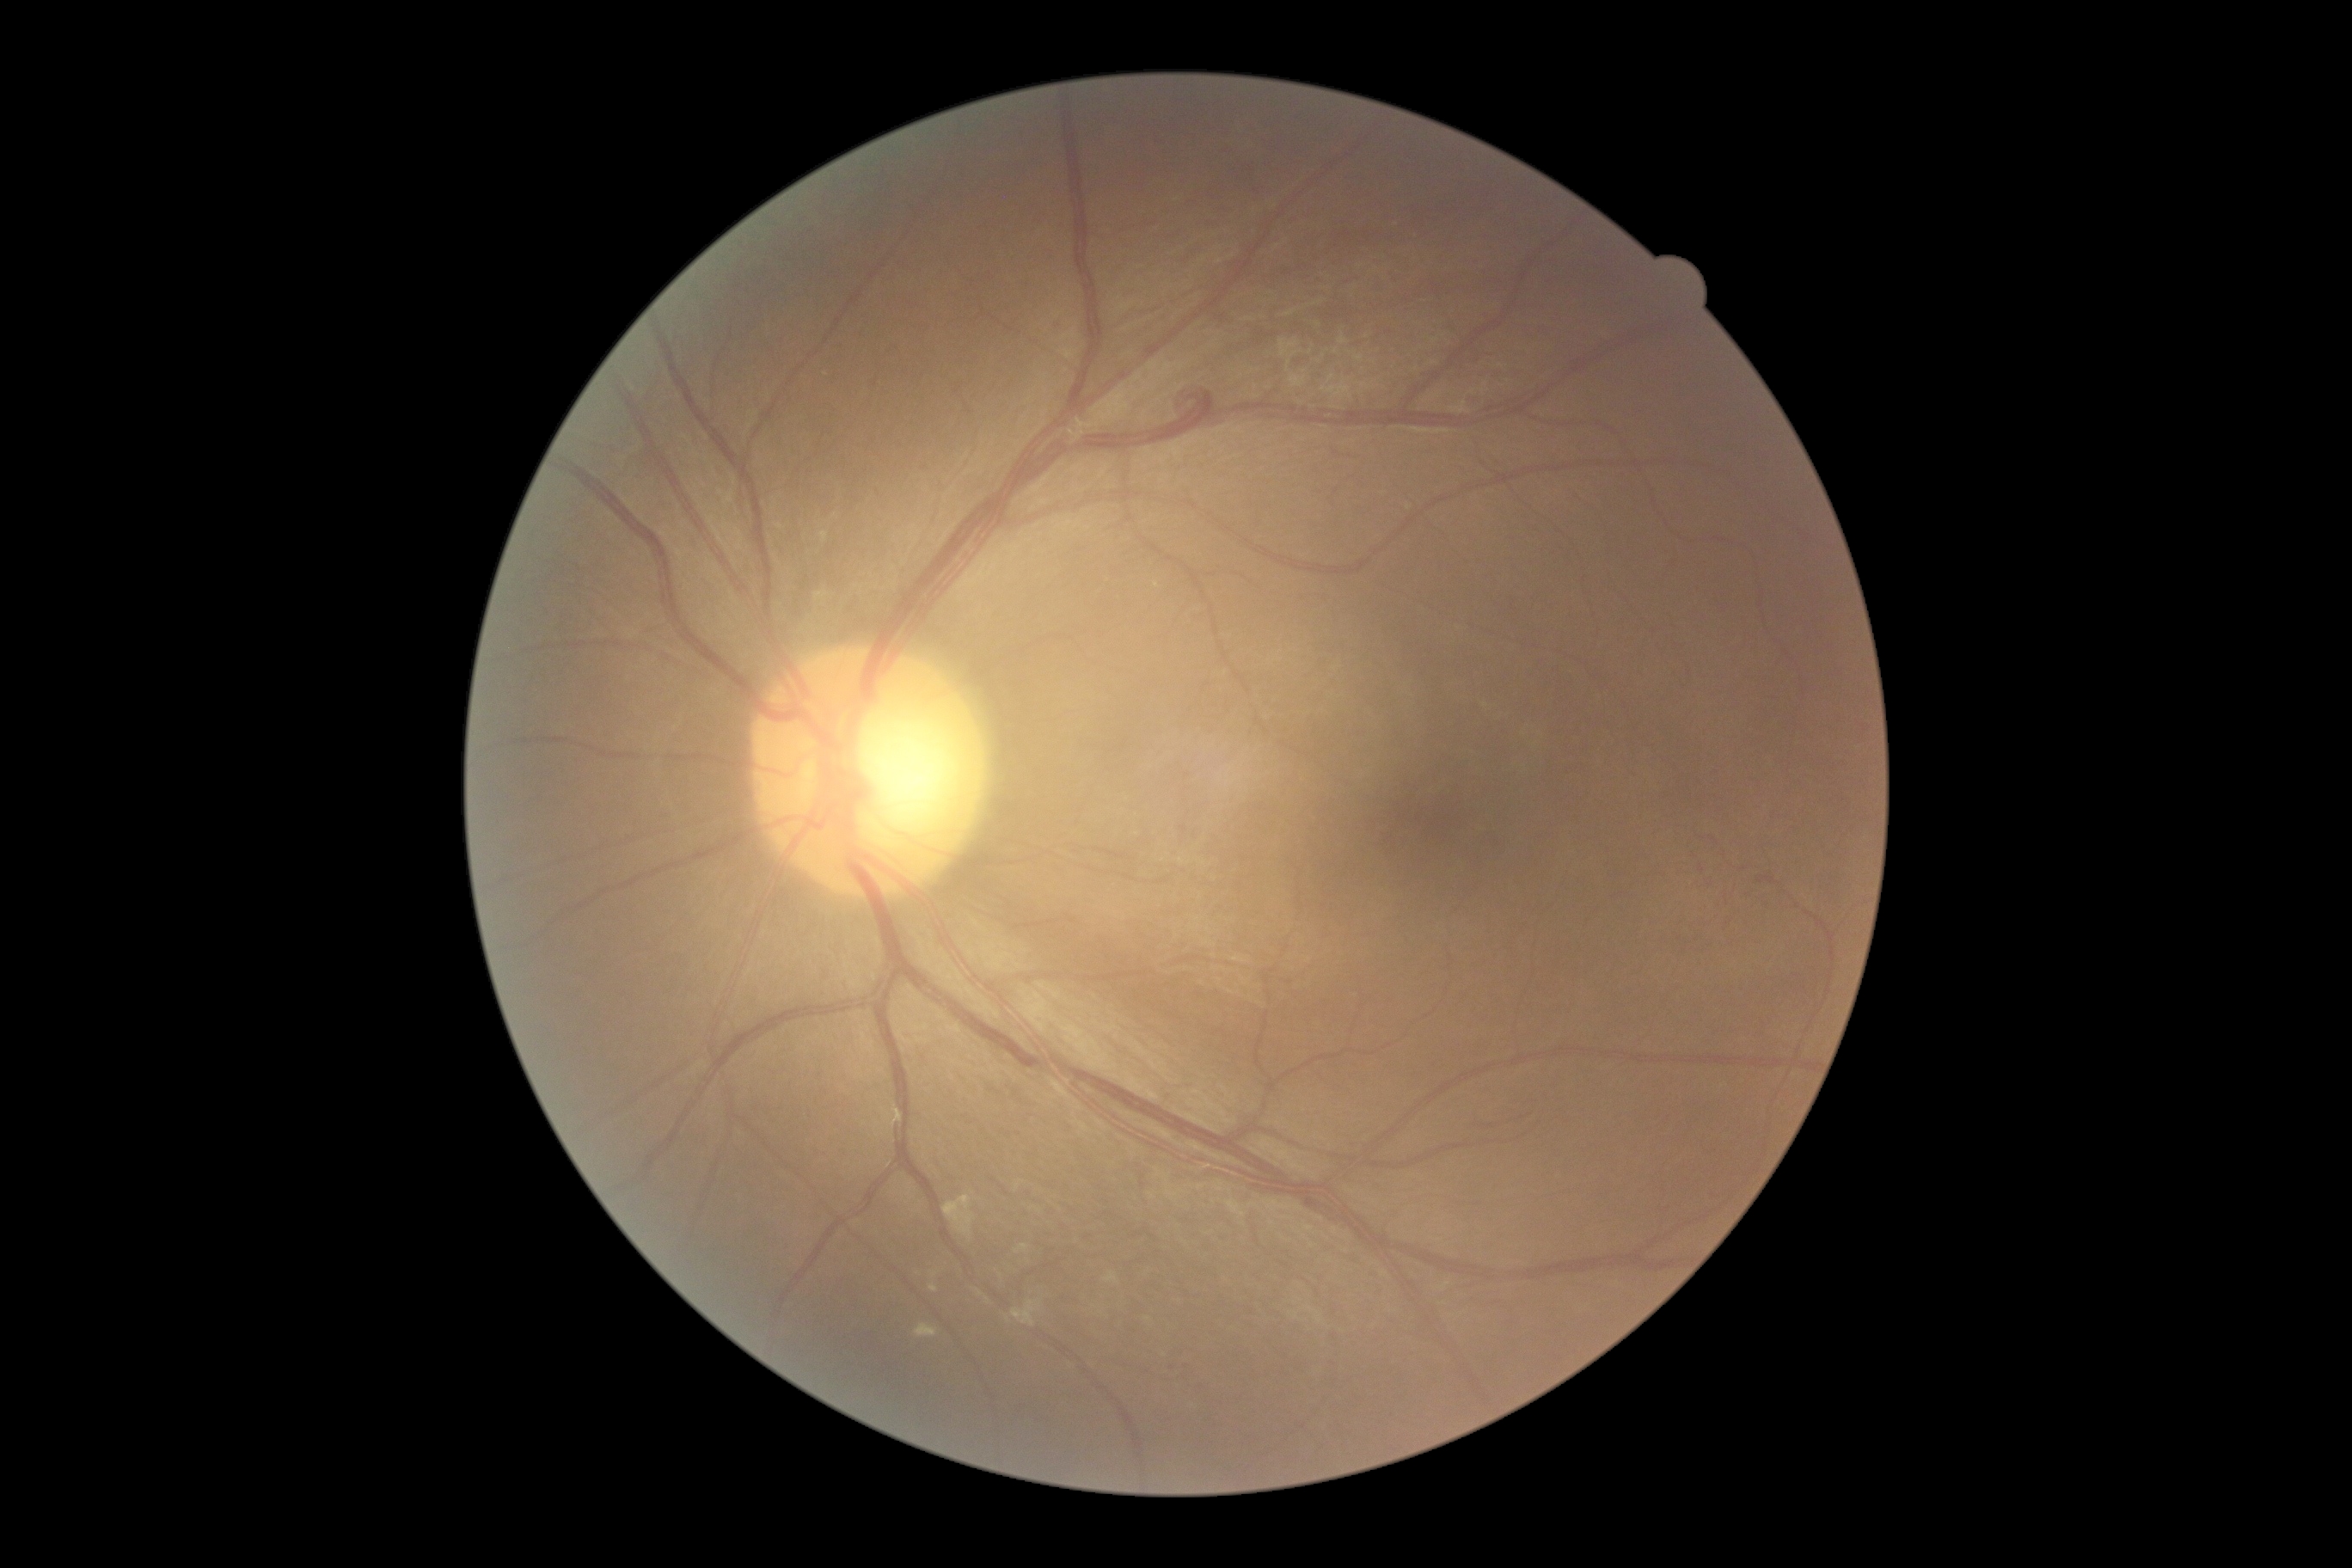
retinopathy grade@1.